FOV: 45 degrees. Fundus photo. 1932 x 1932 pixels:
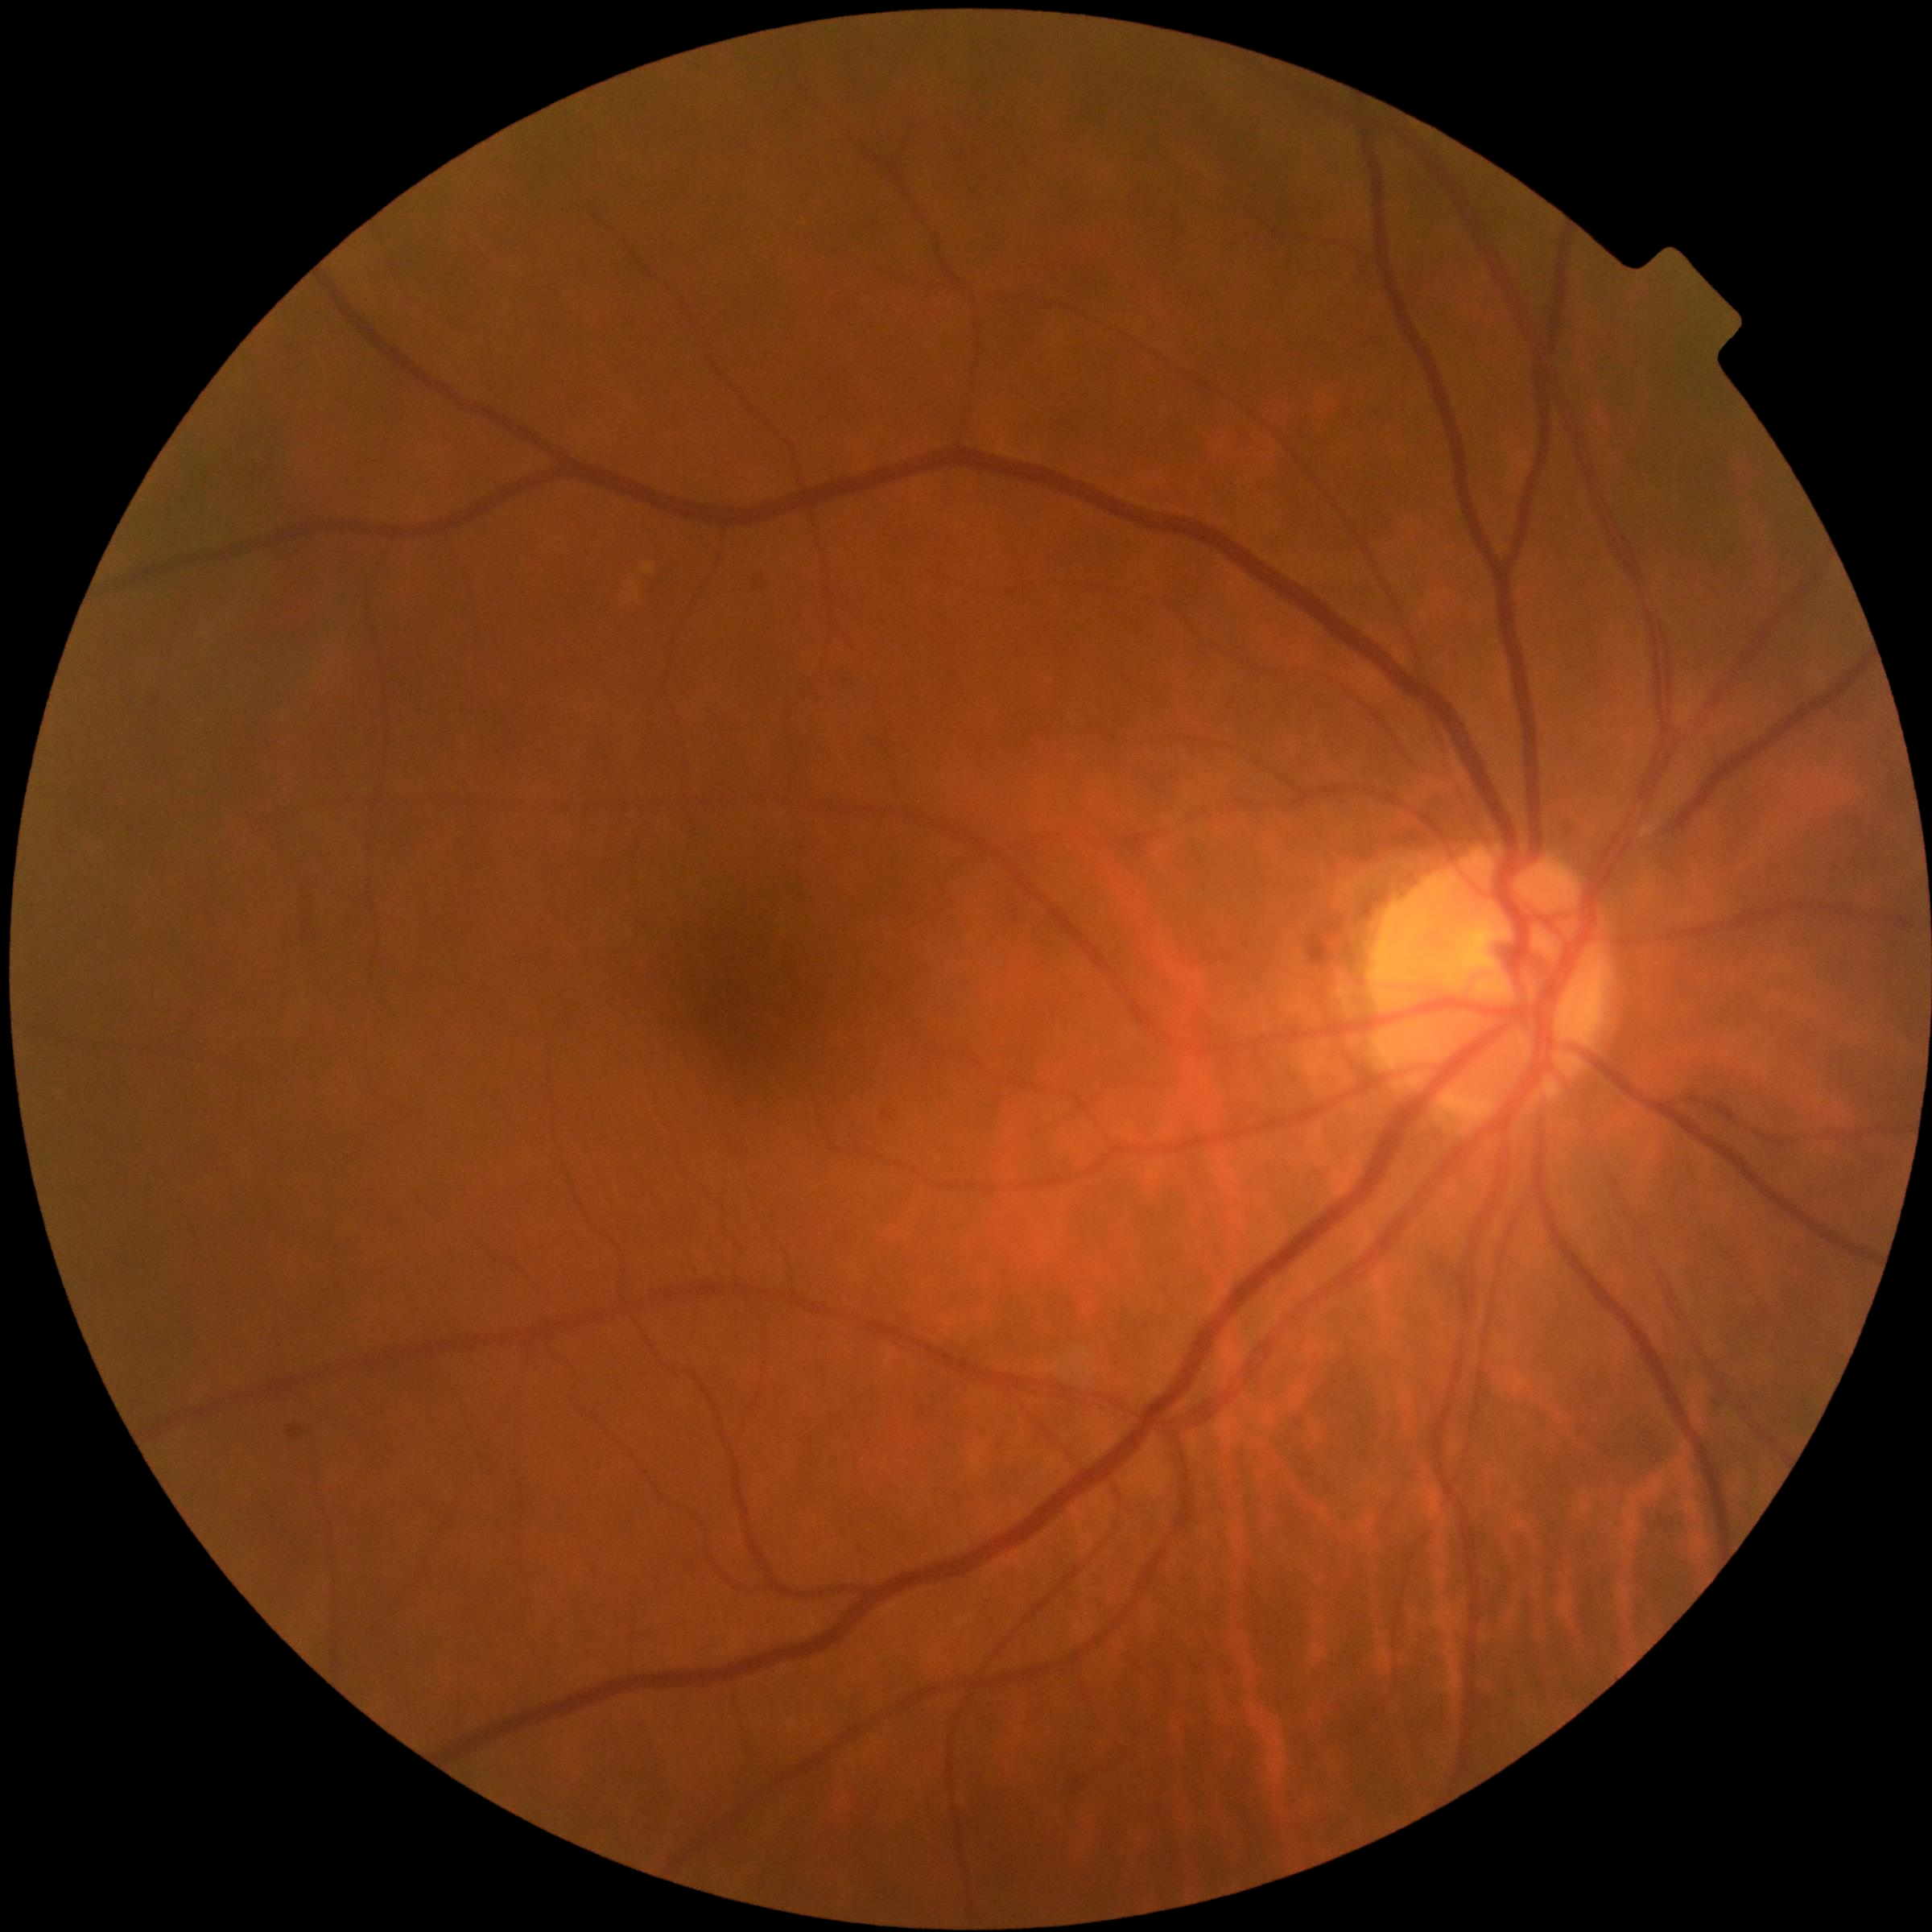

Findings:
– retinopathy grade — no apparent diabetic retinopathy (0)